45° field of view: 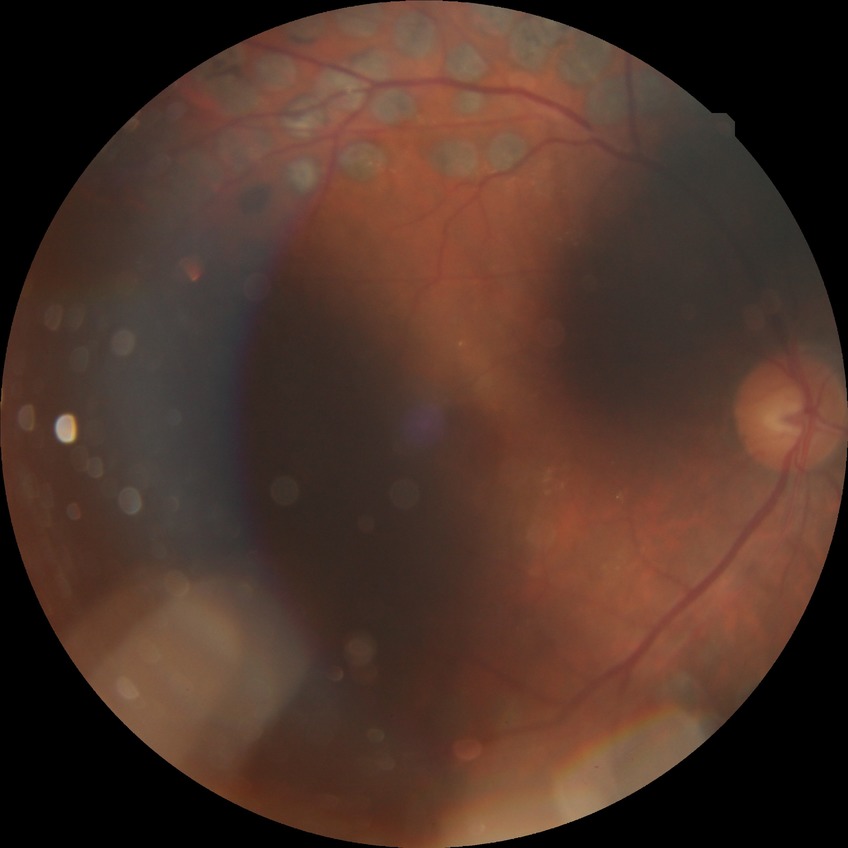
Diabetic retinopathy (DR): PDR (proliferative diabetic retinopathy).